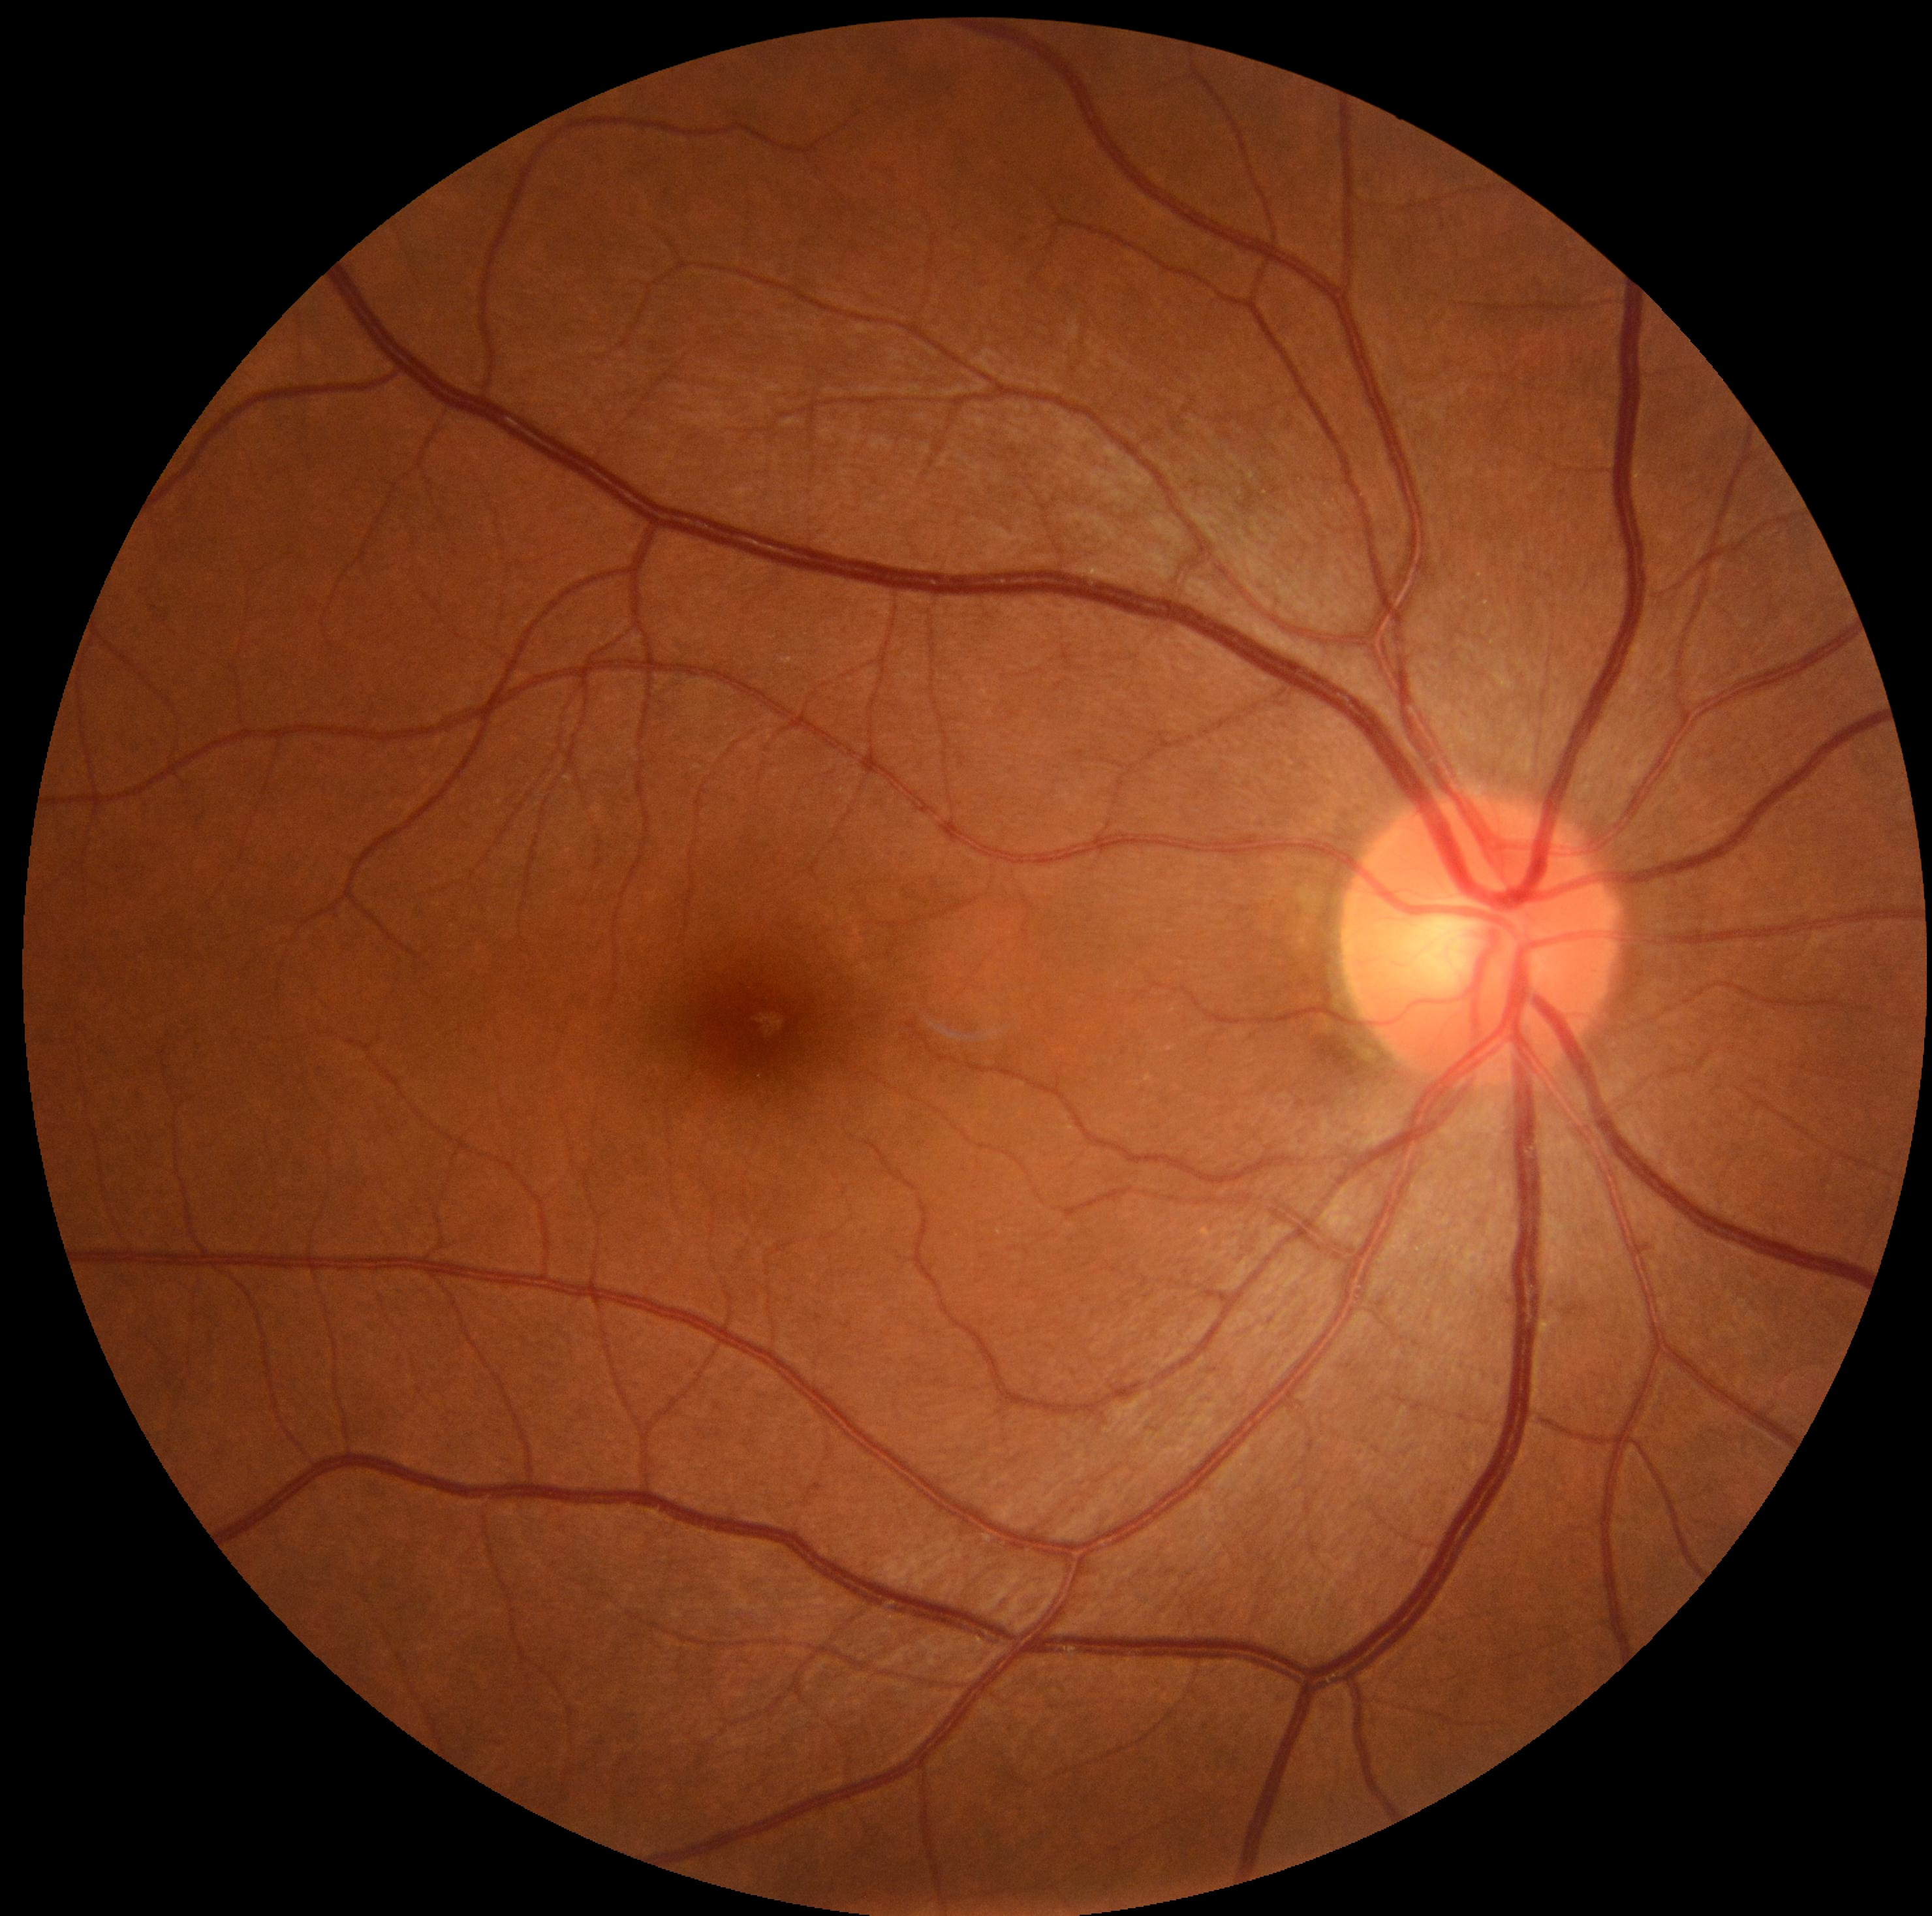

Diabetic retinopathy (DR): 0/4.
No diabetic retinal disease findings.